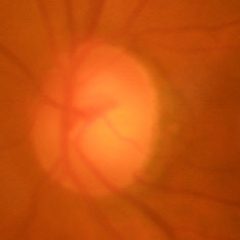
Q: What is the glaucoma diagnosis?
A: No — no evidence of glaucoma.